CFP · non-mydriatic acquisition:
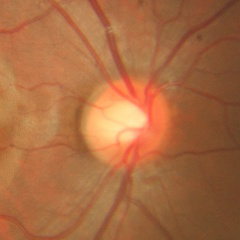 Glaucoma status = no signs of glaucoma.